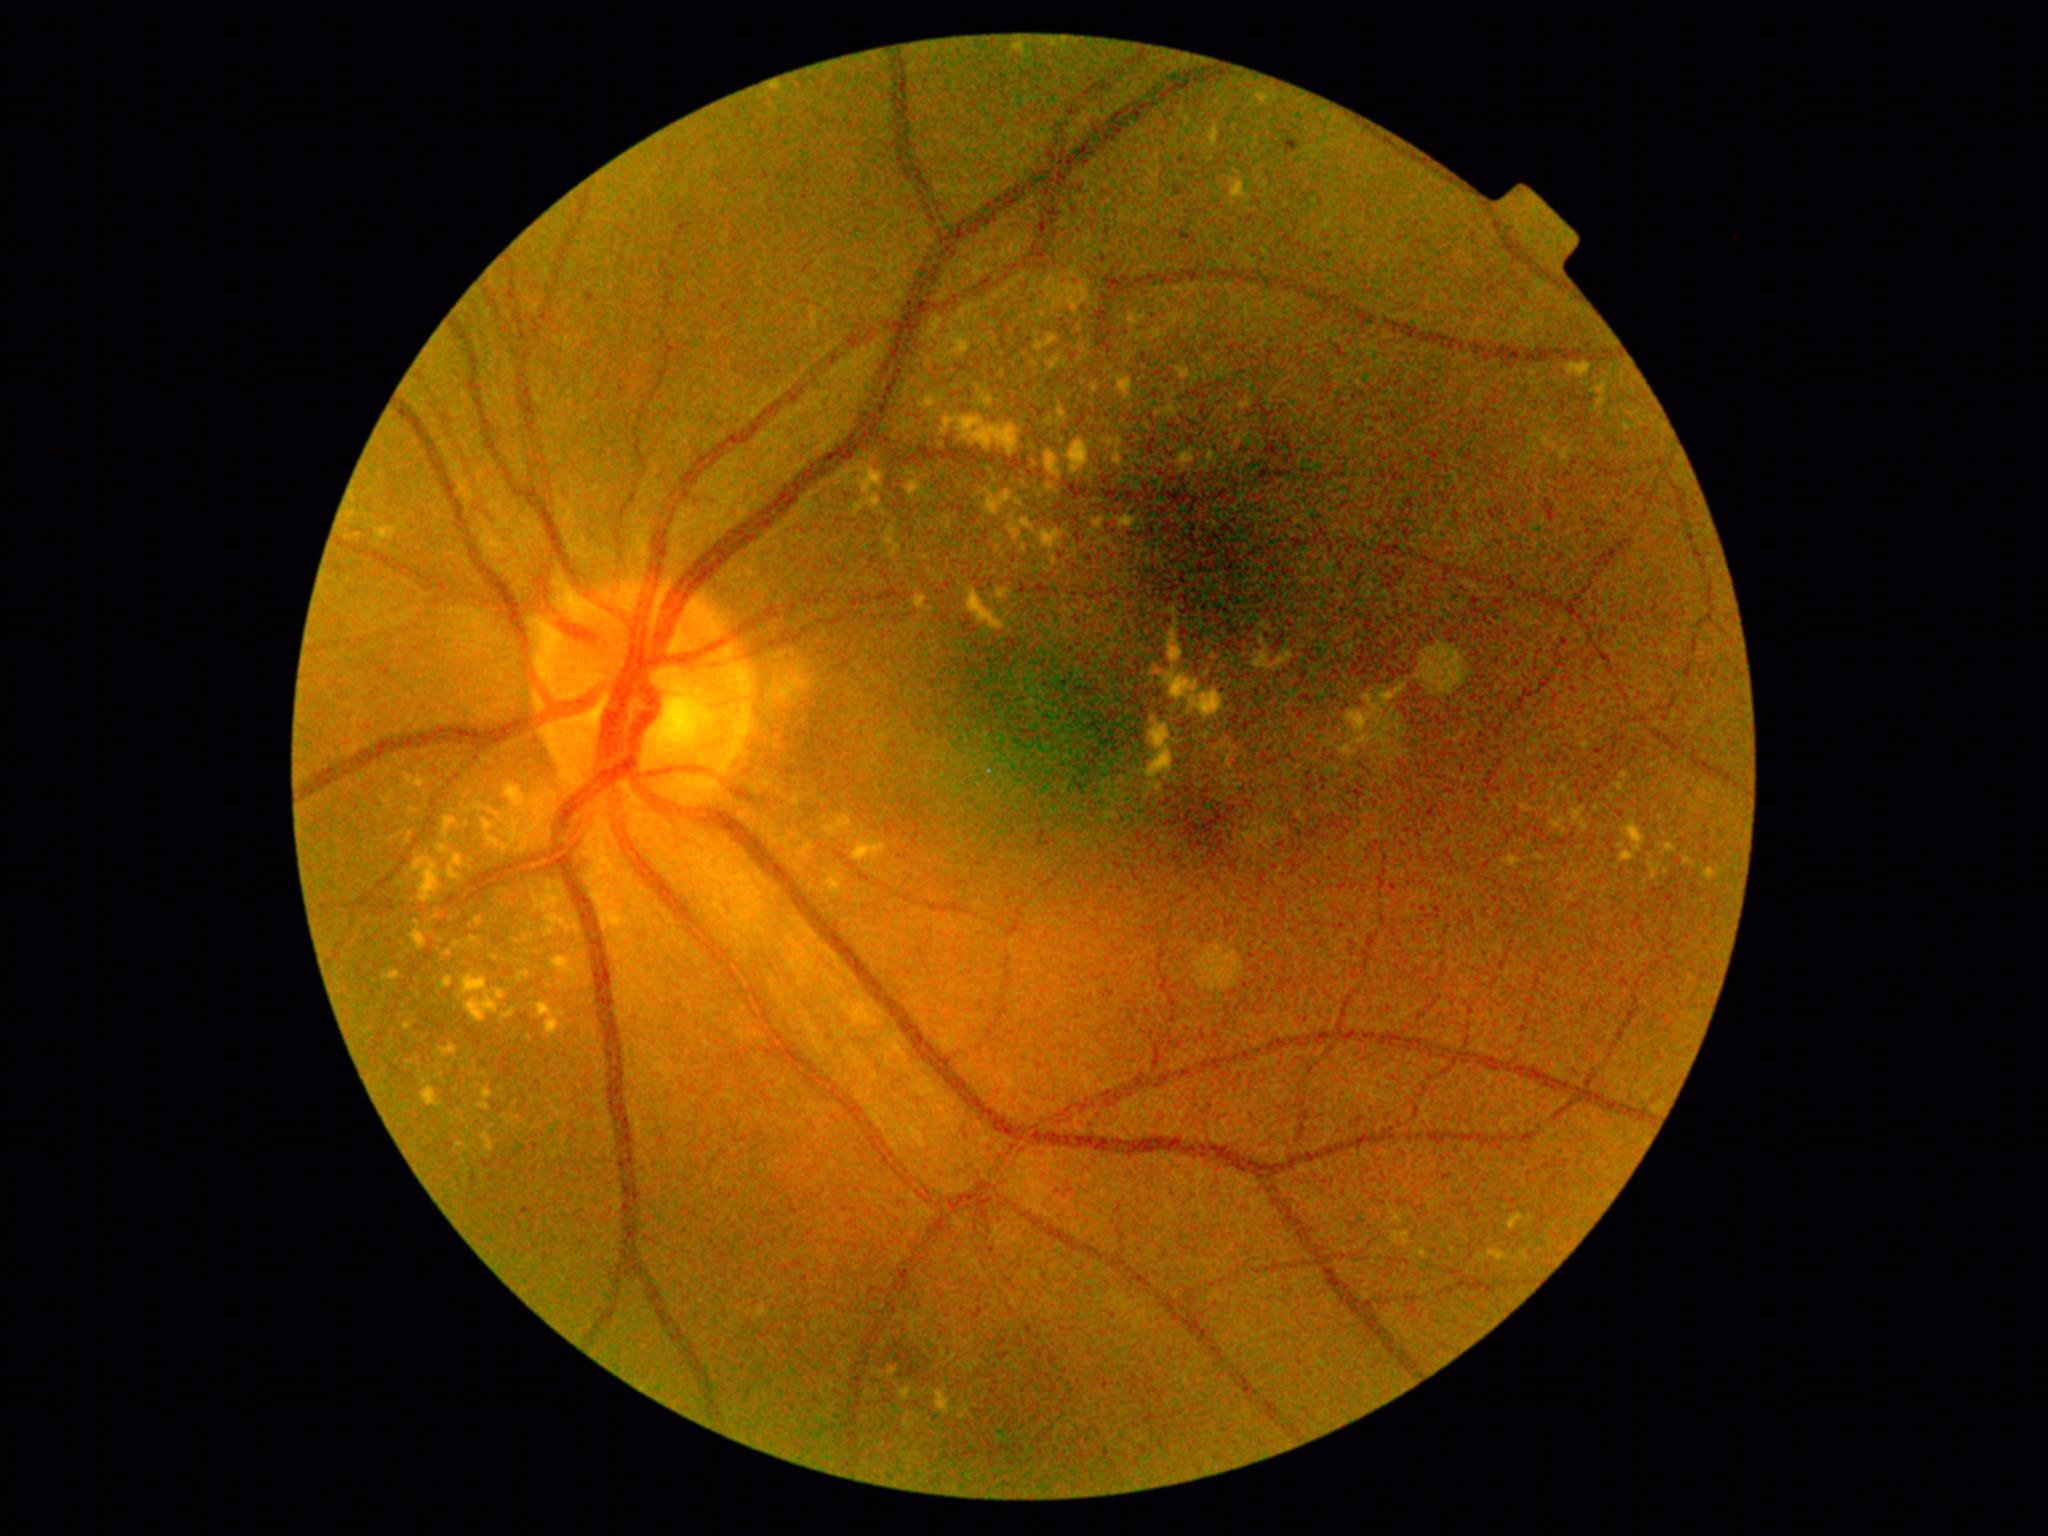

DR: grade 2 (moderate NPDR). EXs are present, including at [left=1341, top=746, right=1351, bottom=753] | [left=537, top=1004, right=553, bottom=1017] | [left=1122, top=519, right=1133, bottom=524] | [left=453, top=855, right=463, bottom=867] | [left=1010, top=526, right=1026, bottom=554] | [left=987, top=400, right=996, bottom=410] | [left=408, top=776, right=411, bottom=784] | [left=443, top=1046, right=456, bottom=1054] | [left=1254, top=650, right=1294, bottom=670] | [left=603, top=912, right=623, bottom=927] | [left=1598, top=384, right=1606, bottom=394] | [left=378, top=529, right=391, bottom=540]. EXs (small, approximate centers) near Point(893, 1372) | Point(1244, 406) | Point(538, 824) | Point(532, 830) | Point(1241, 444).